Color fundus photograph — 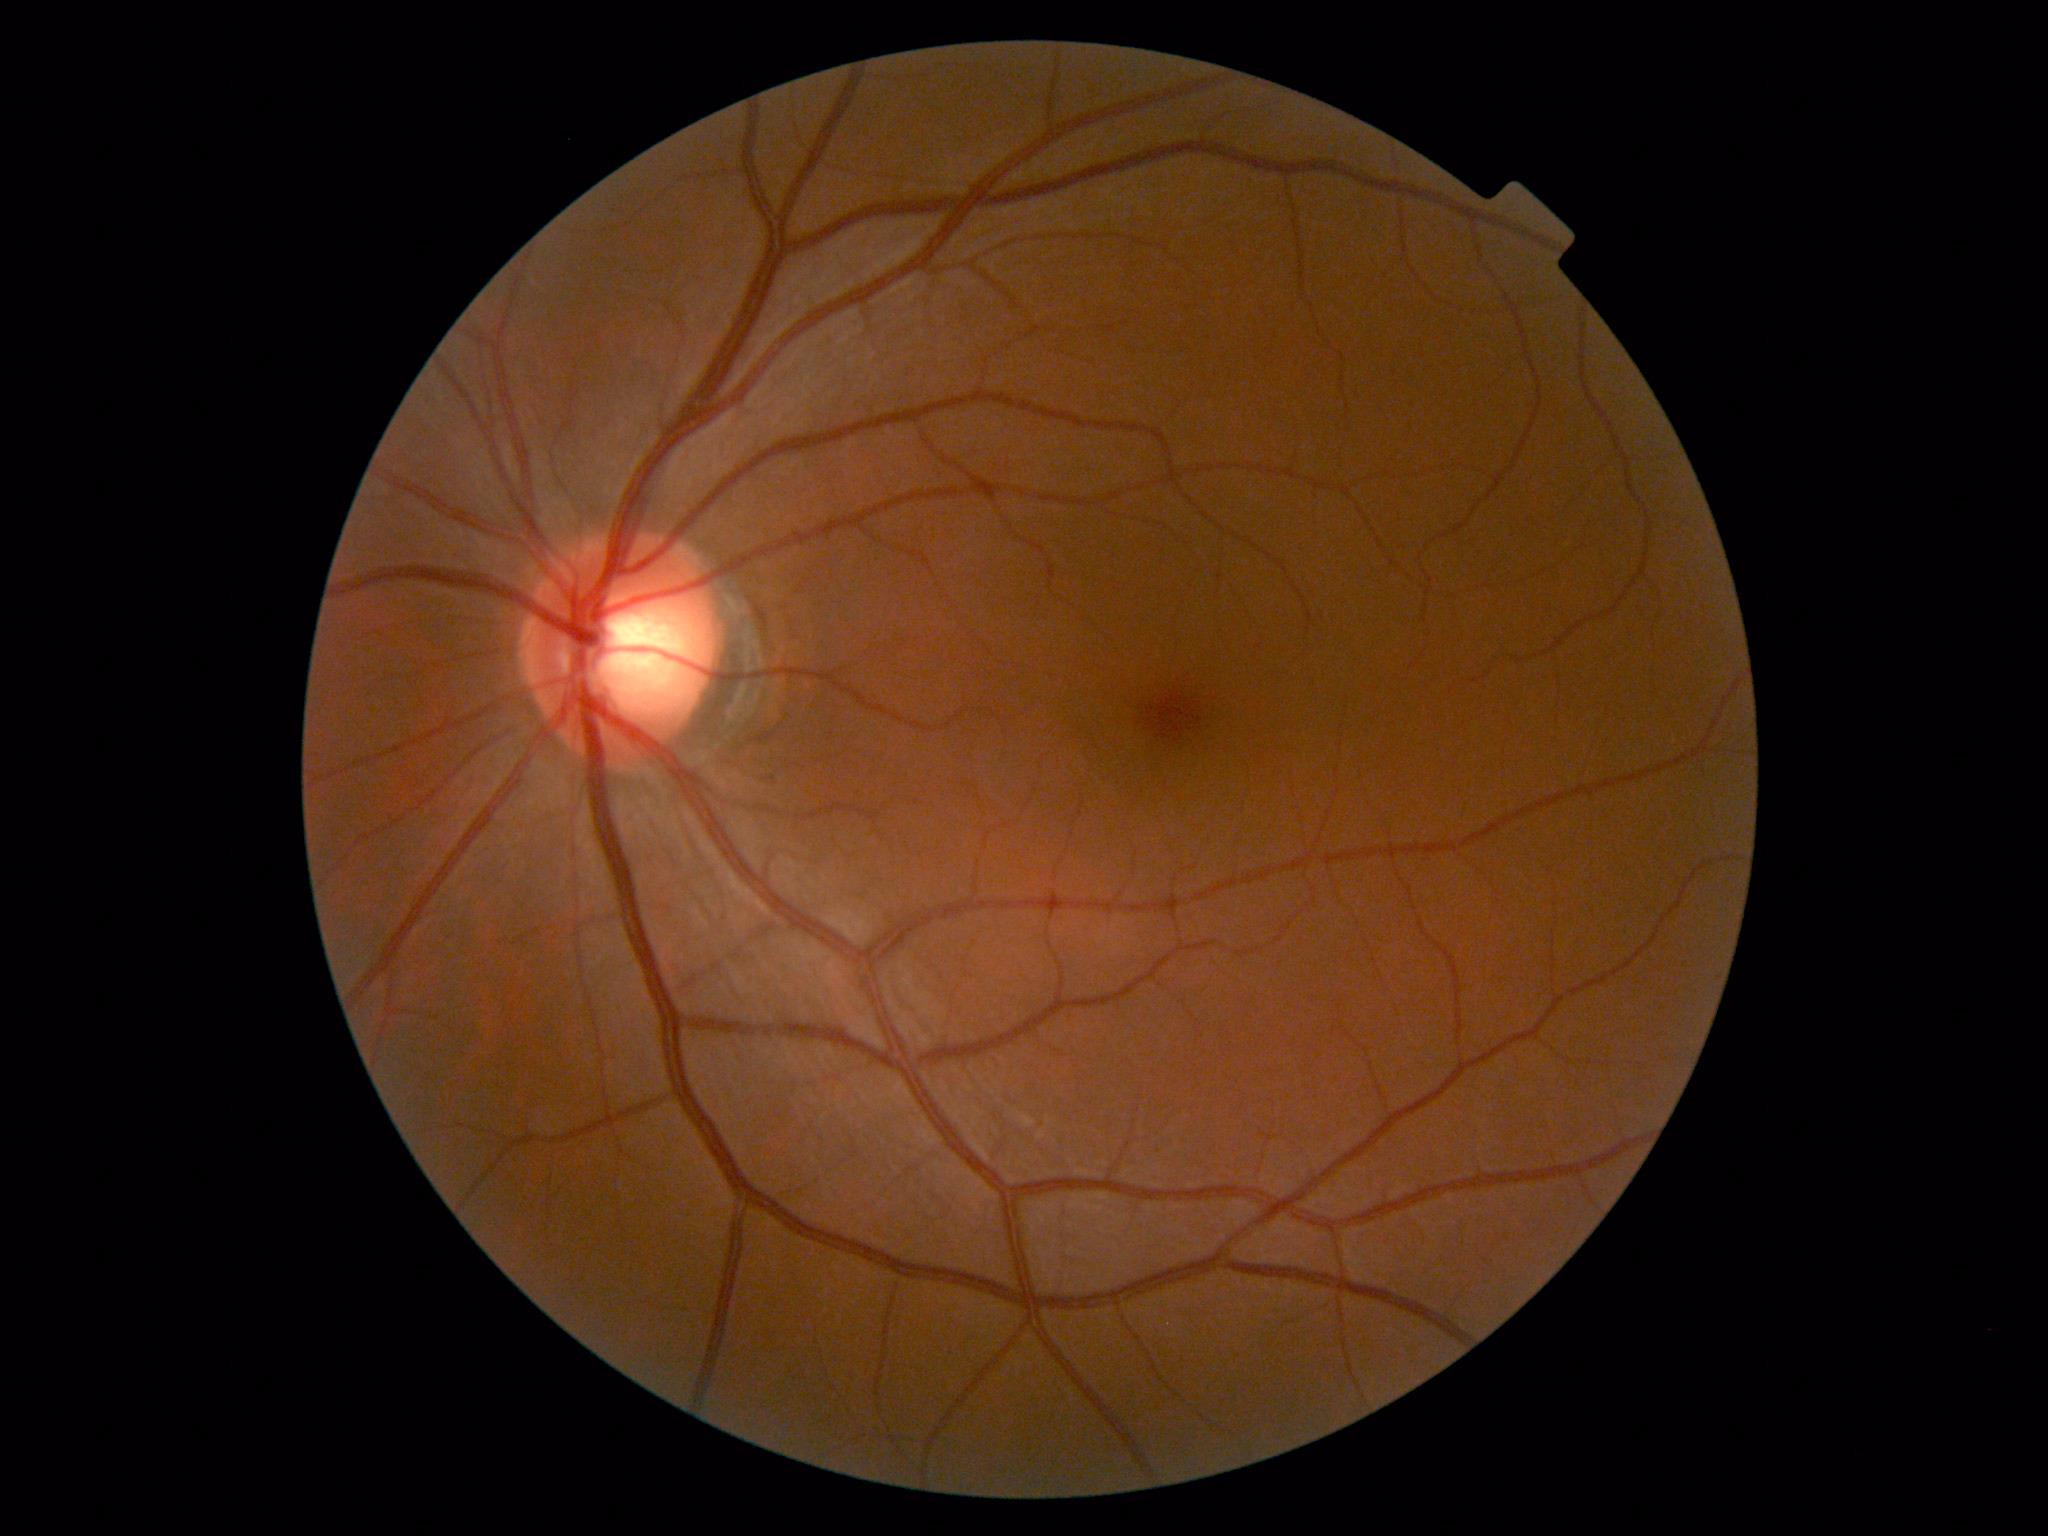 - DR severity — grade 0 (no apparent retinopathy)